45° FOV: 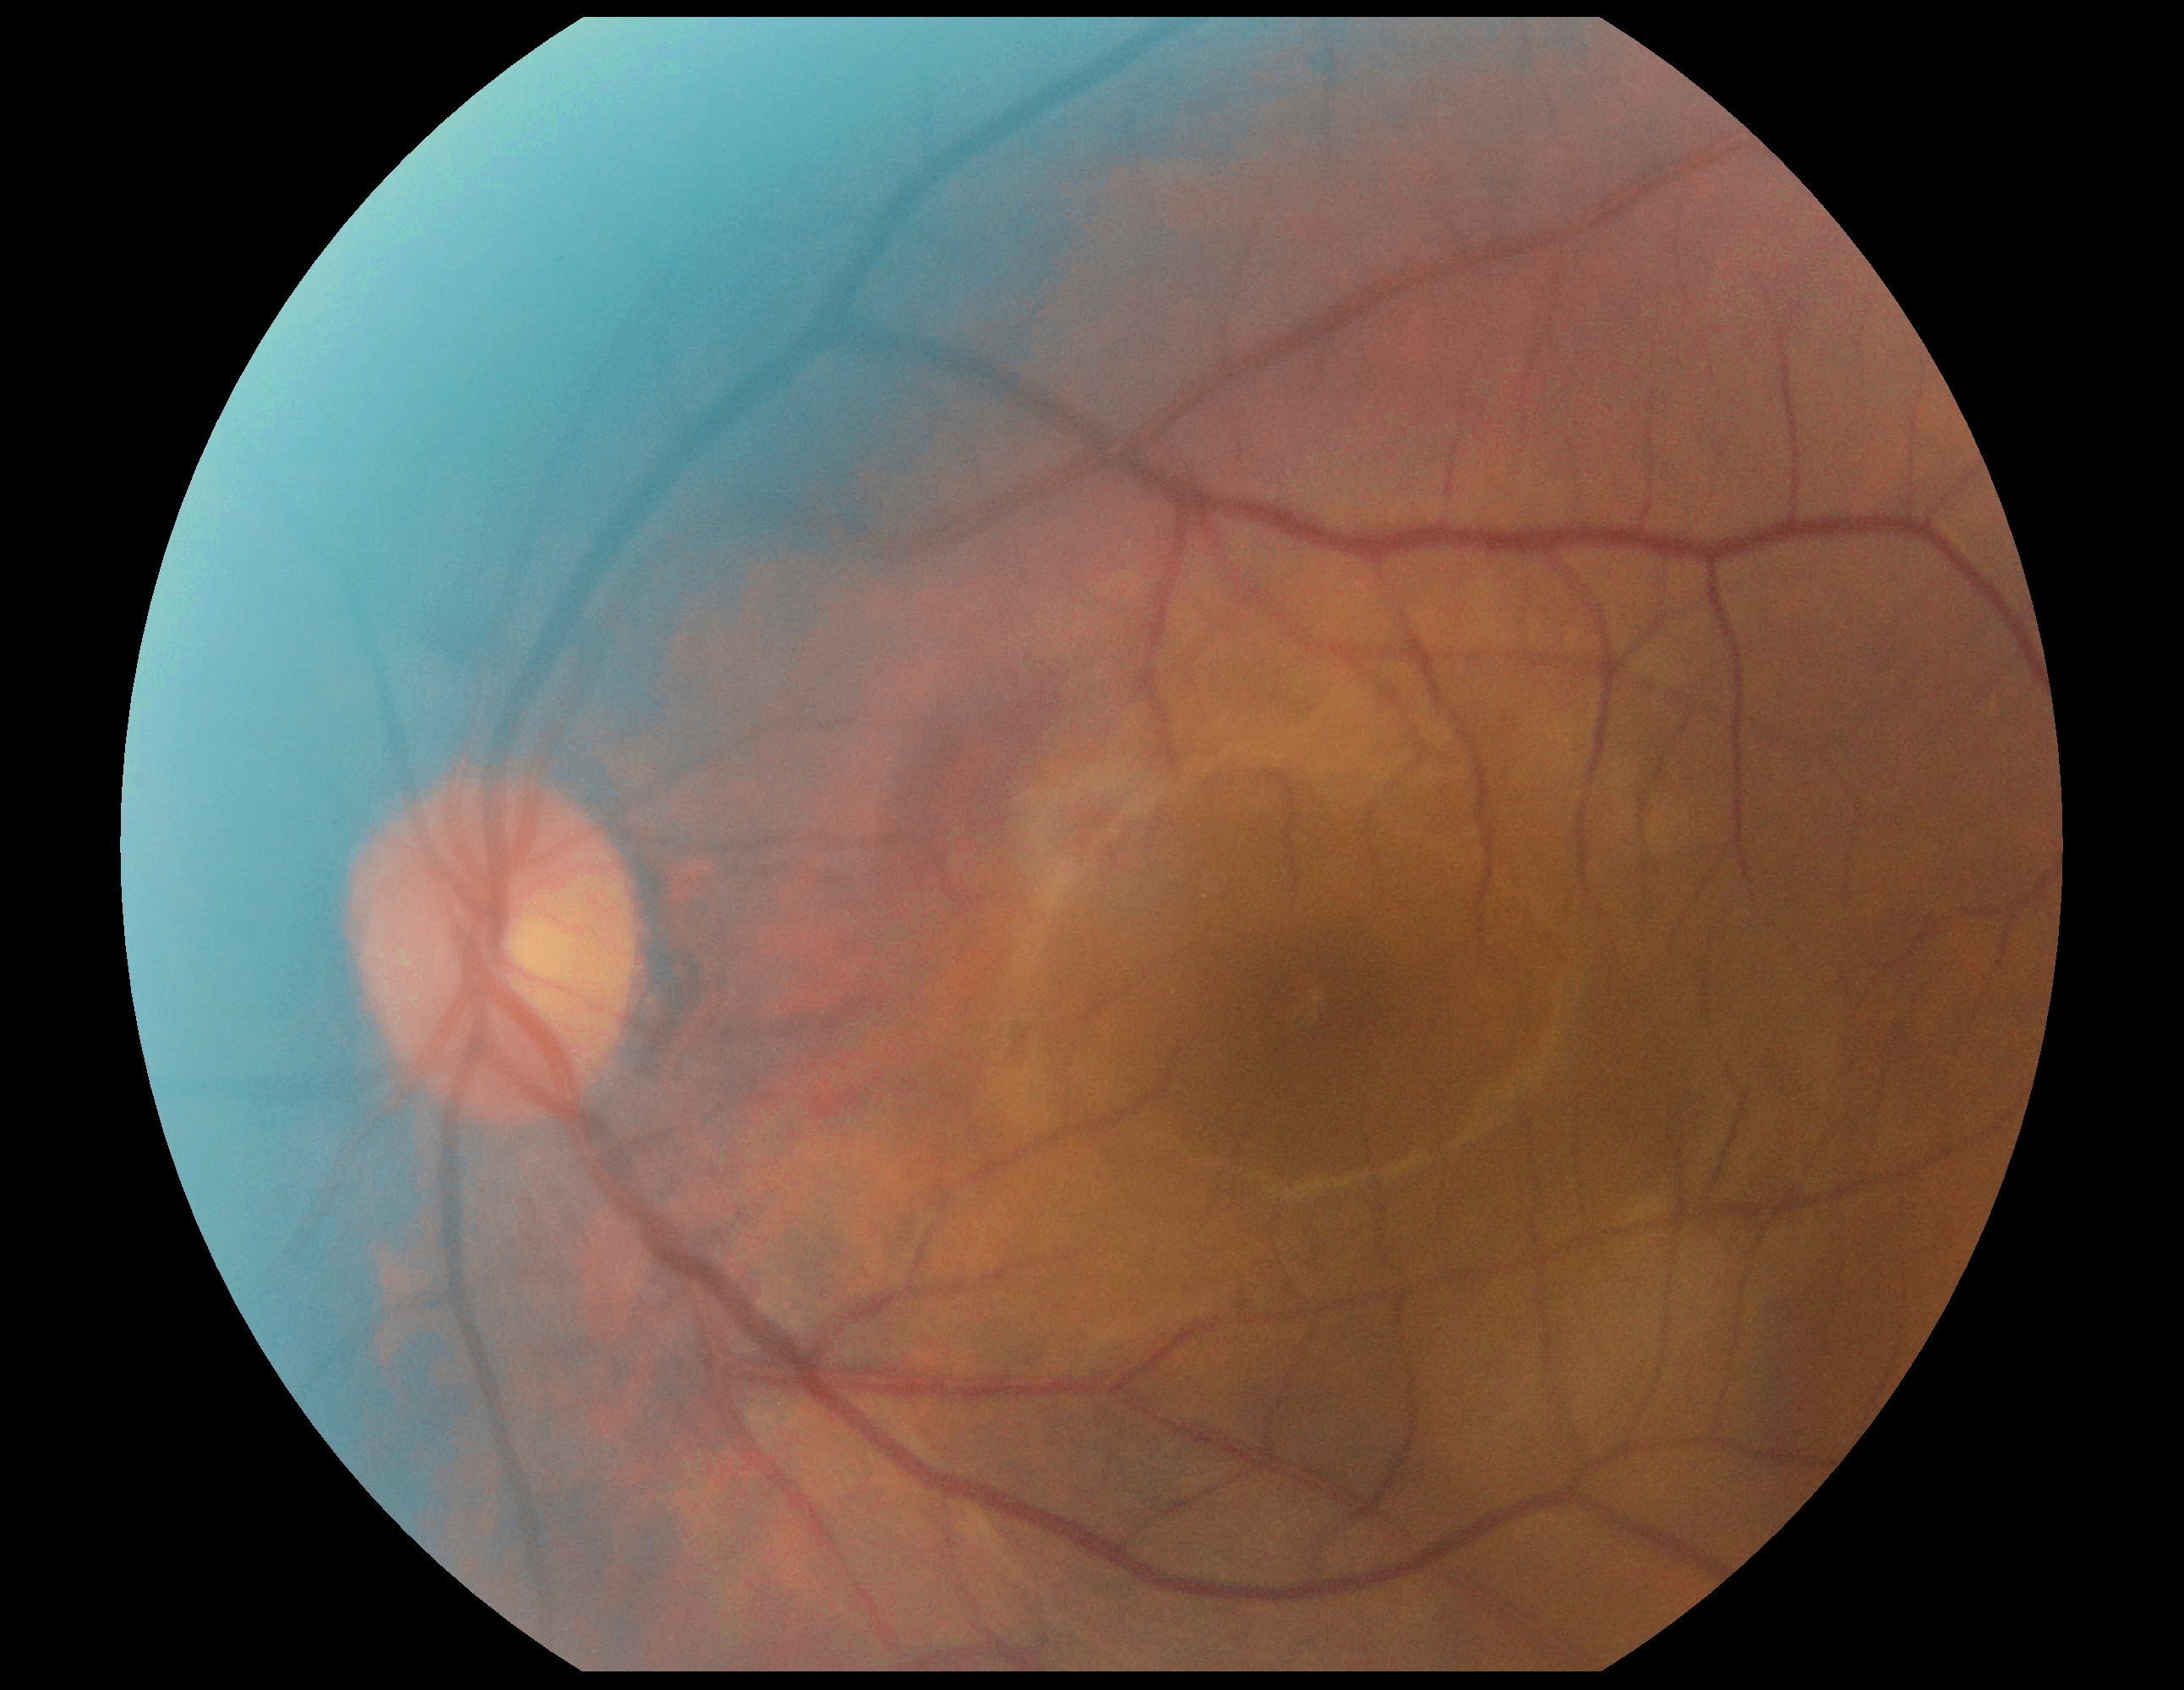

diabetic retinopathy (DR): no apparent retinopathy (grade 0).